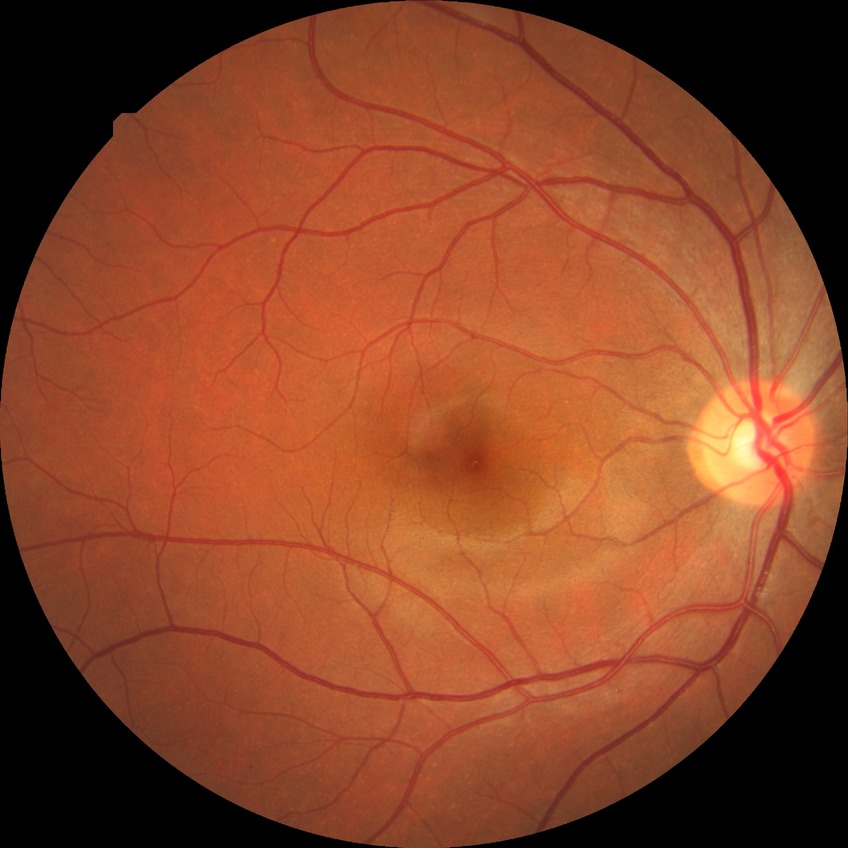

Diabetic retinopathy (DR): no diabetic retinopathy (NDR).